Infant wide-field retinal image · 1440x1080px:
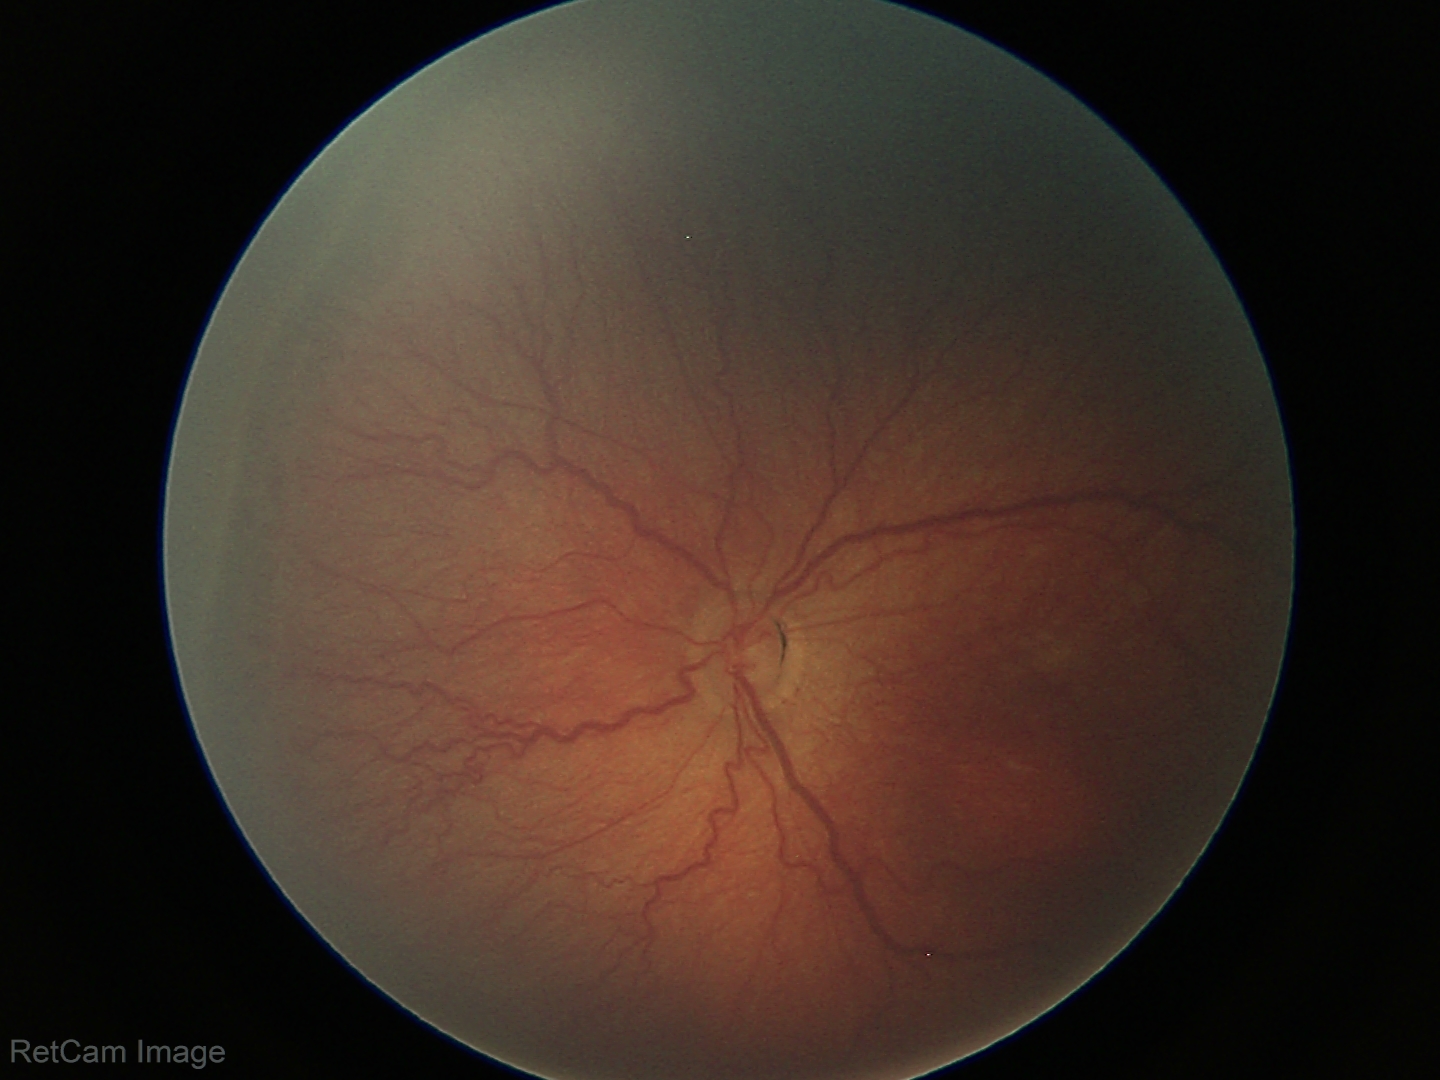
Screening series with ROP stage 3. Without plus disease.